2352 by 1568 pixels, 45° FOV:
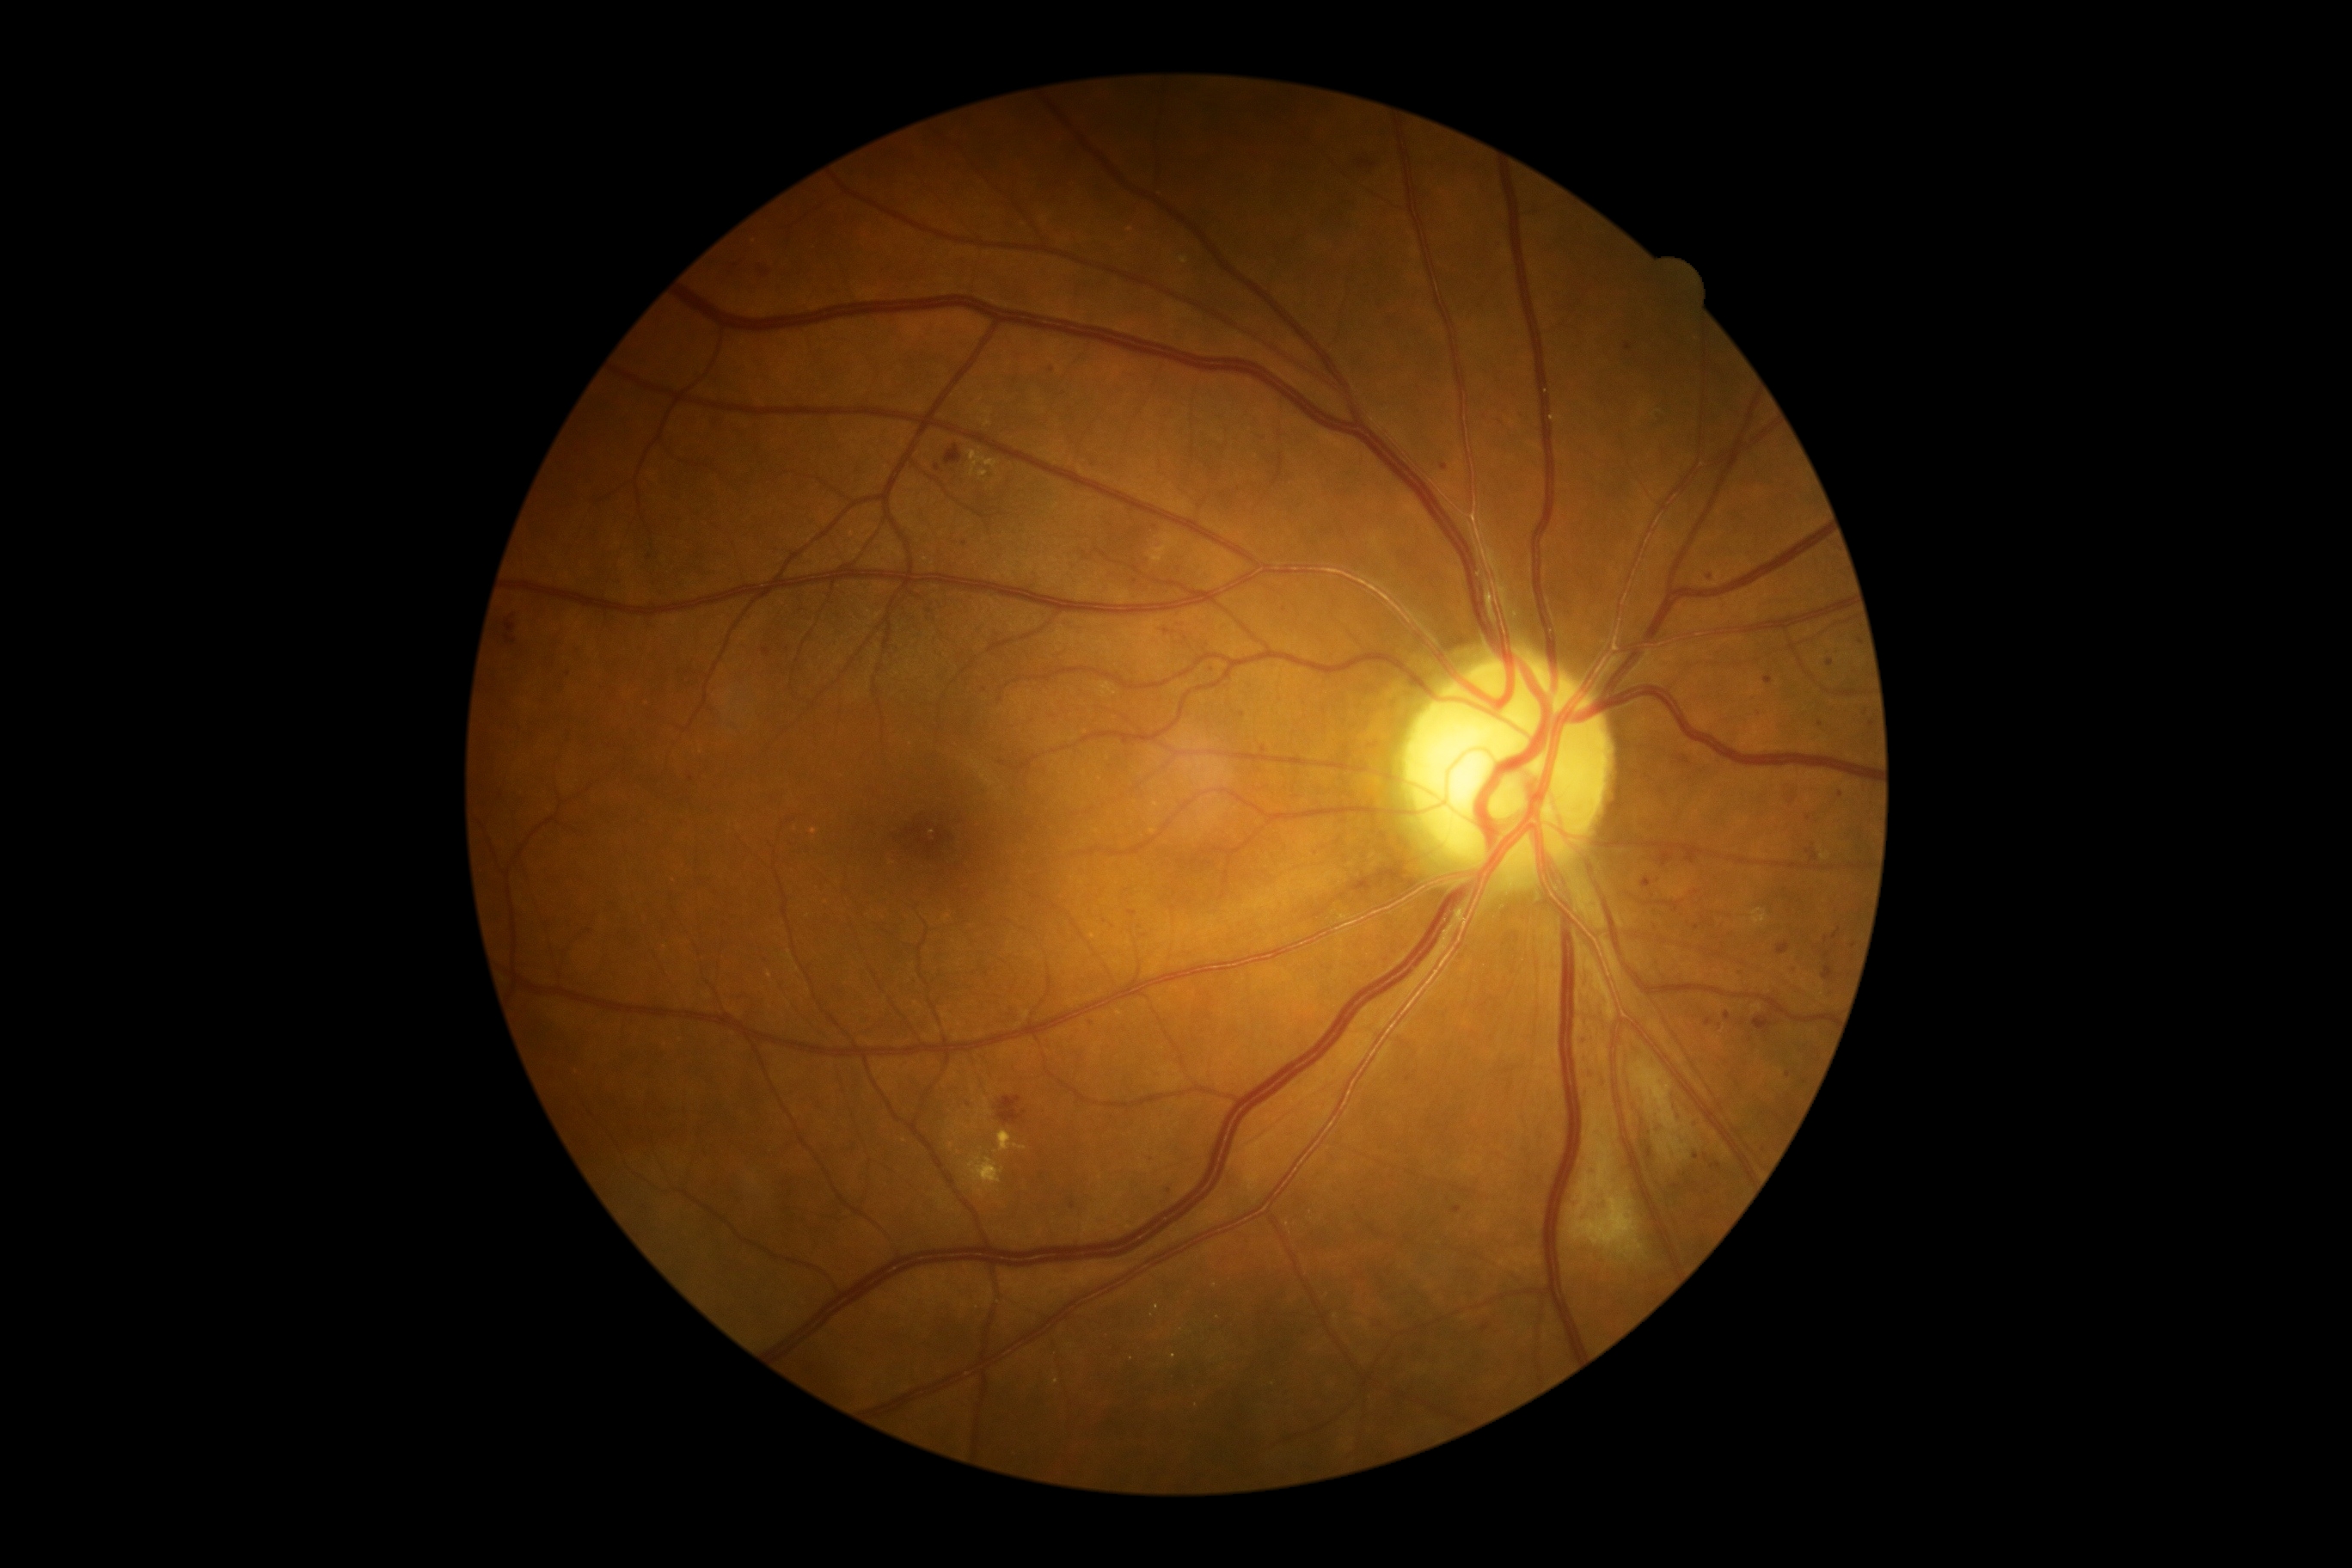 DR grade is moderate non-proliferative diabetic retinopathy (2)
Selected lesions:
MAs (partial): x1=1792 y1=965 x2=1799 y2=974; x1=1834 y1=929 x2=1842 y2=940; x1=763 y1=649 x2=771 y2=658; x1=1588 y1=1067 x2=1595 y2=1077; x1=1626 y1=1216 x2=1631 y2=1225; x1=1643 y1=878 x2=1653 y2=888; x1=1777 y1=941 x2=1791 y2=955
Additional small MAs near (649,558); (1052,369); (1628,346); (1168,1190); (1676,1187); (1765,1151); (1697,1157); (1820,724); (692,779); (1830,662); (1073,1206)